Diabetic retinopathy graded by the modified Davis classification — 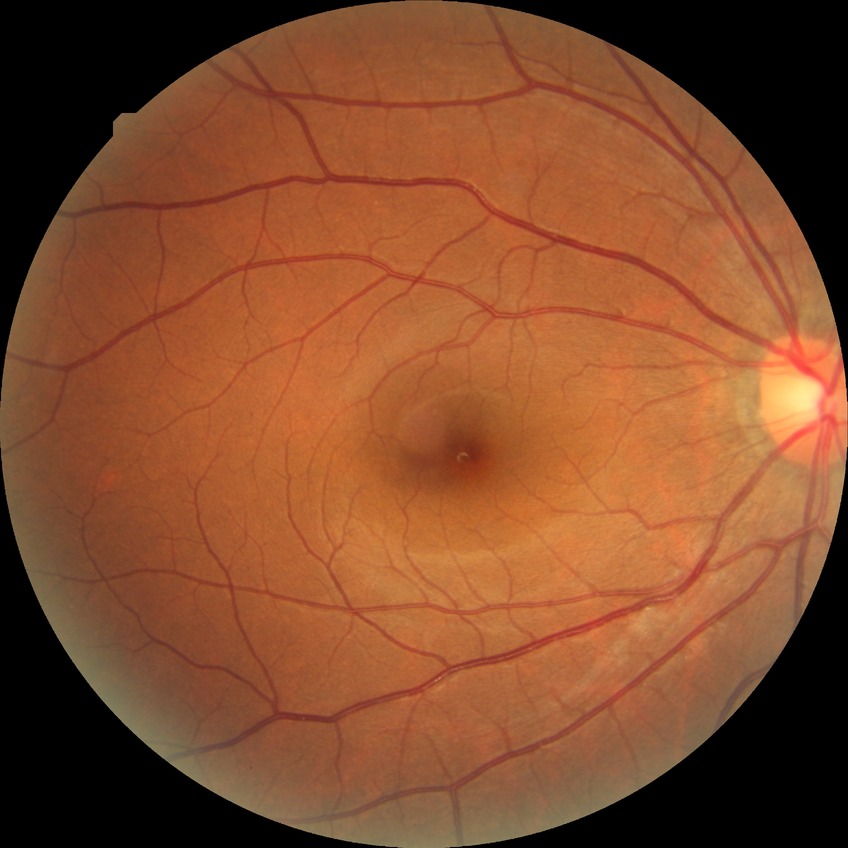
Diabetic retinopathy (DR): SDR (simple diabetic retinopathy).